Image size 2346x1568.
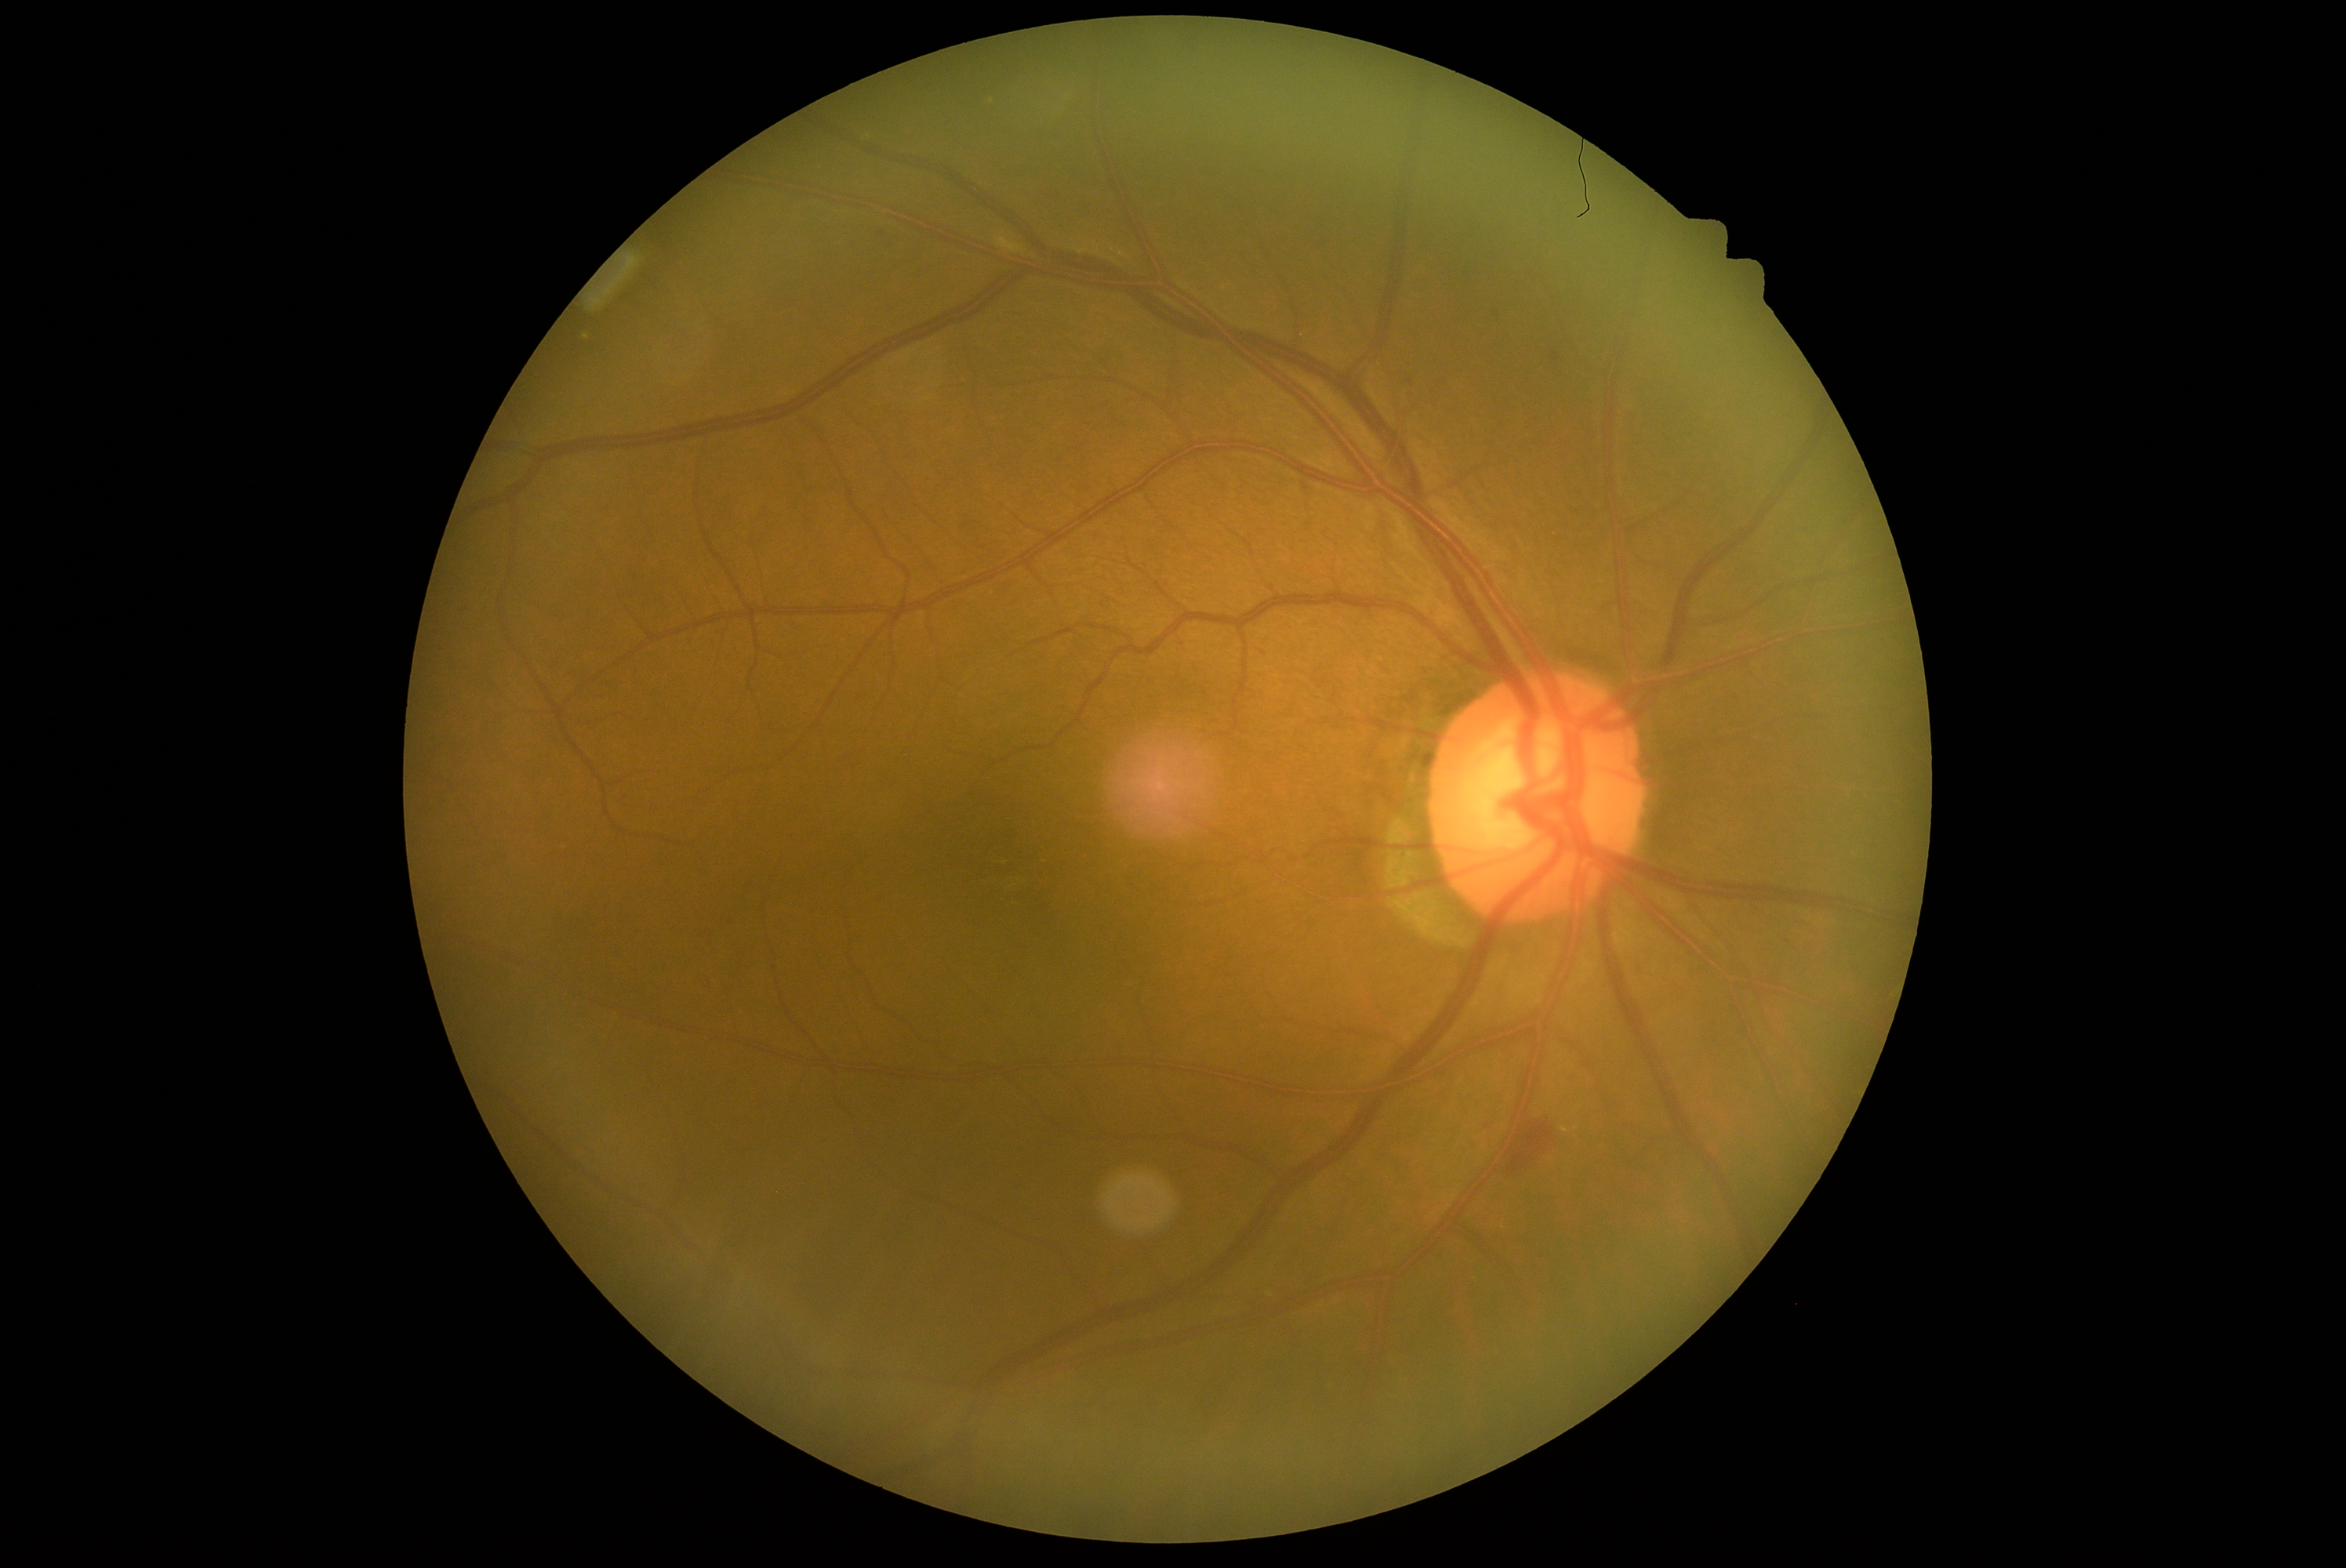
DR severity: moderate non-proliferative diabetic retinopathy (grade 2), DR class: non-proliferative diabetic retinopathy.